NIDEK AFC-230; 45° FOV: 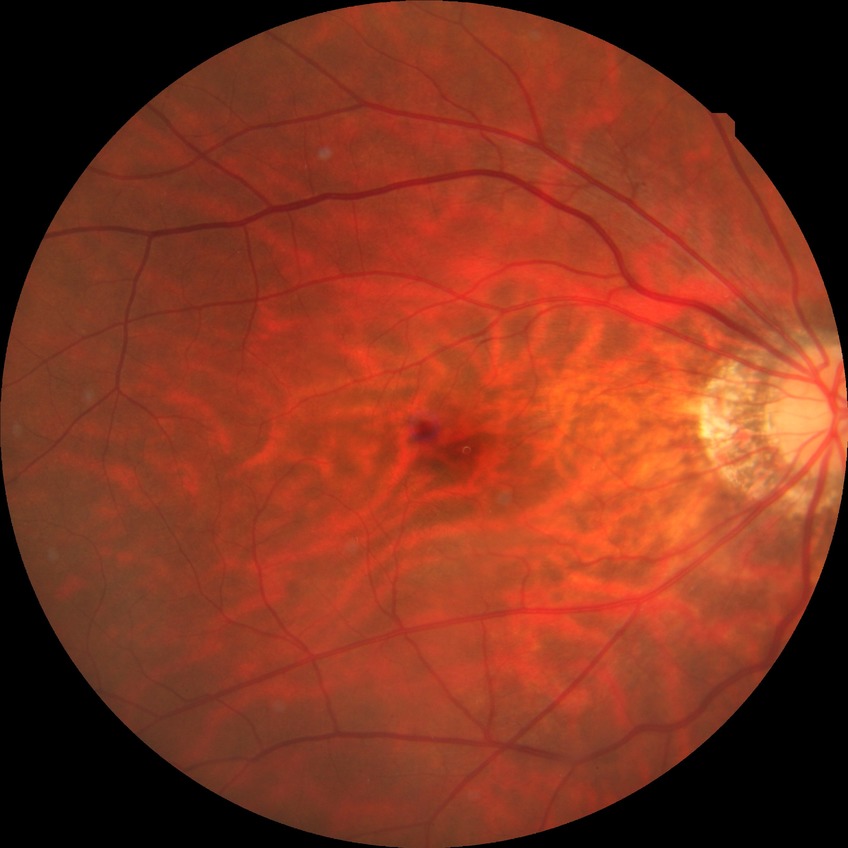 Diabetic retinopathy (DR): NDR (no diabetic retinopathy).